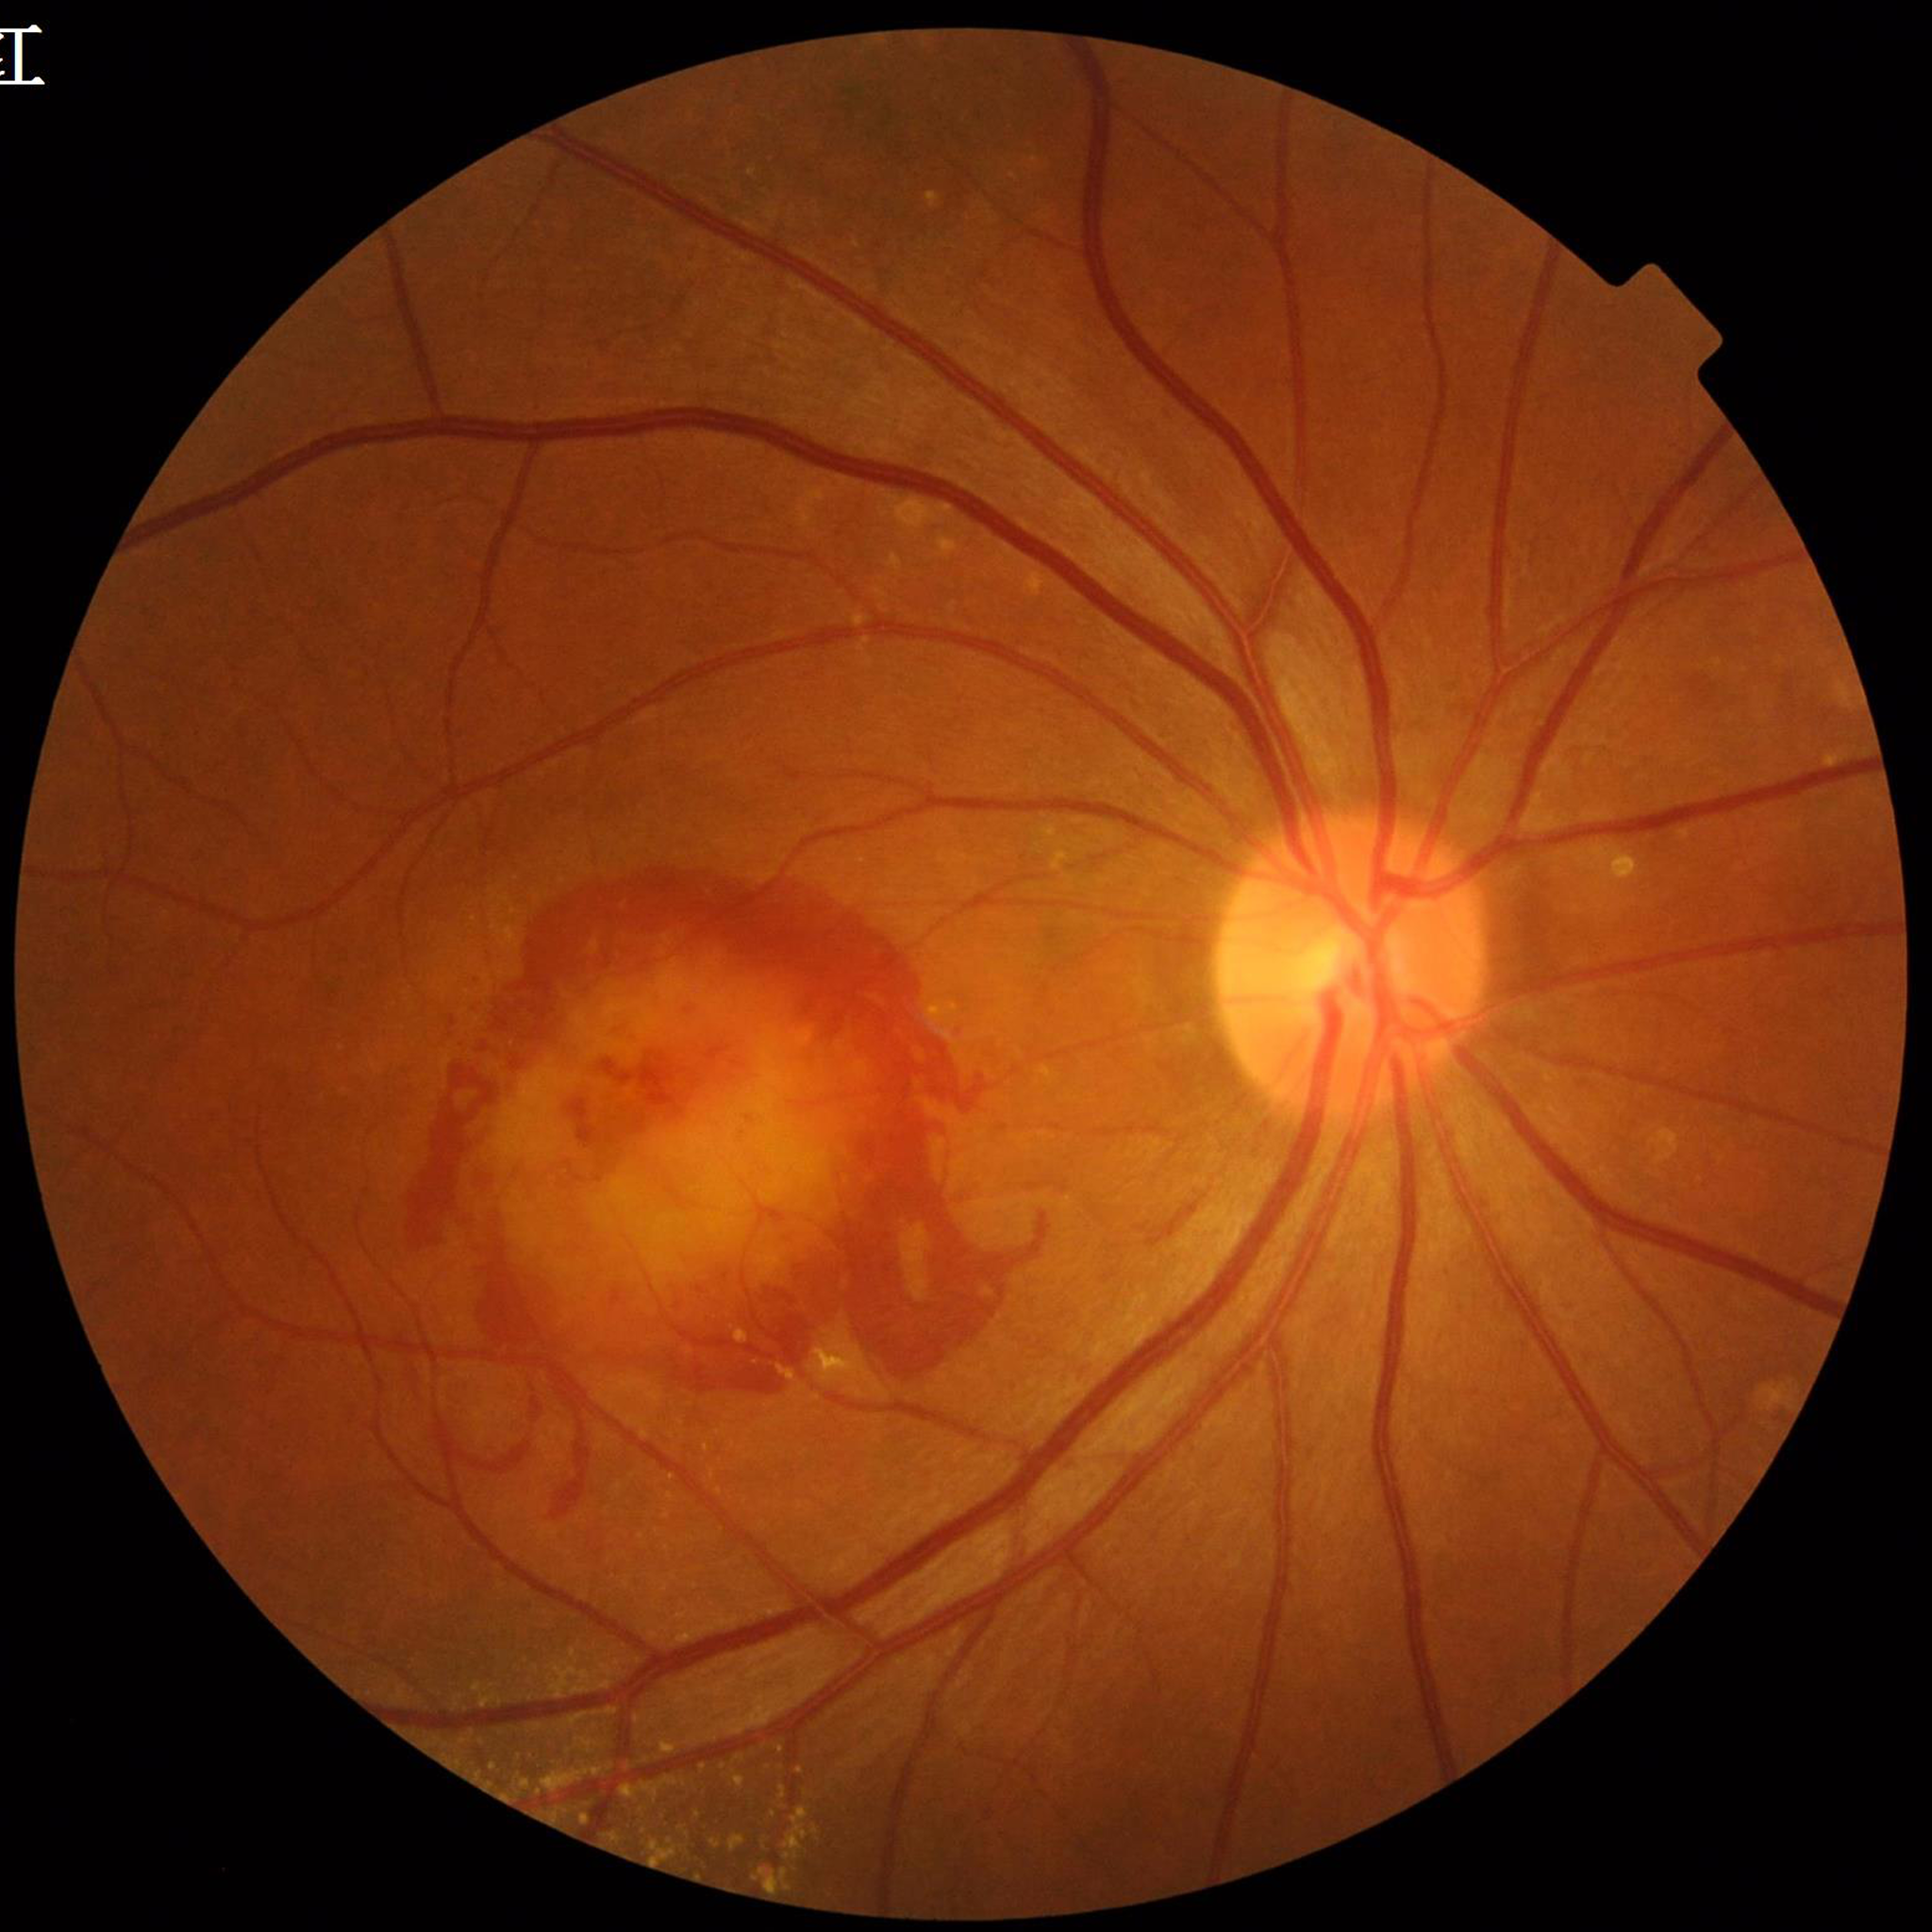
Disease class: age-related macular degeneration.